Retinal fundus photograph:
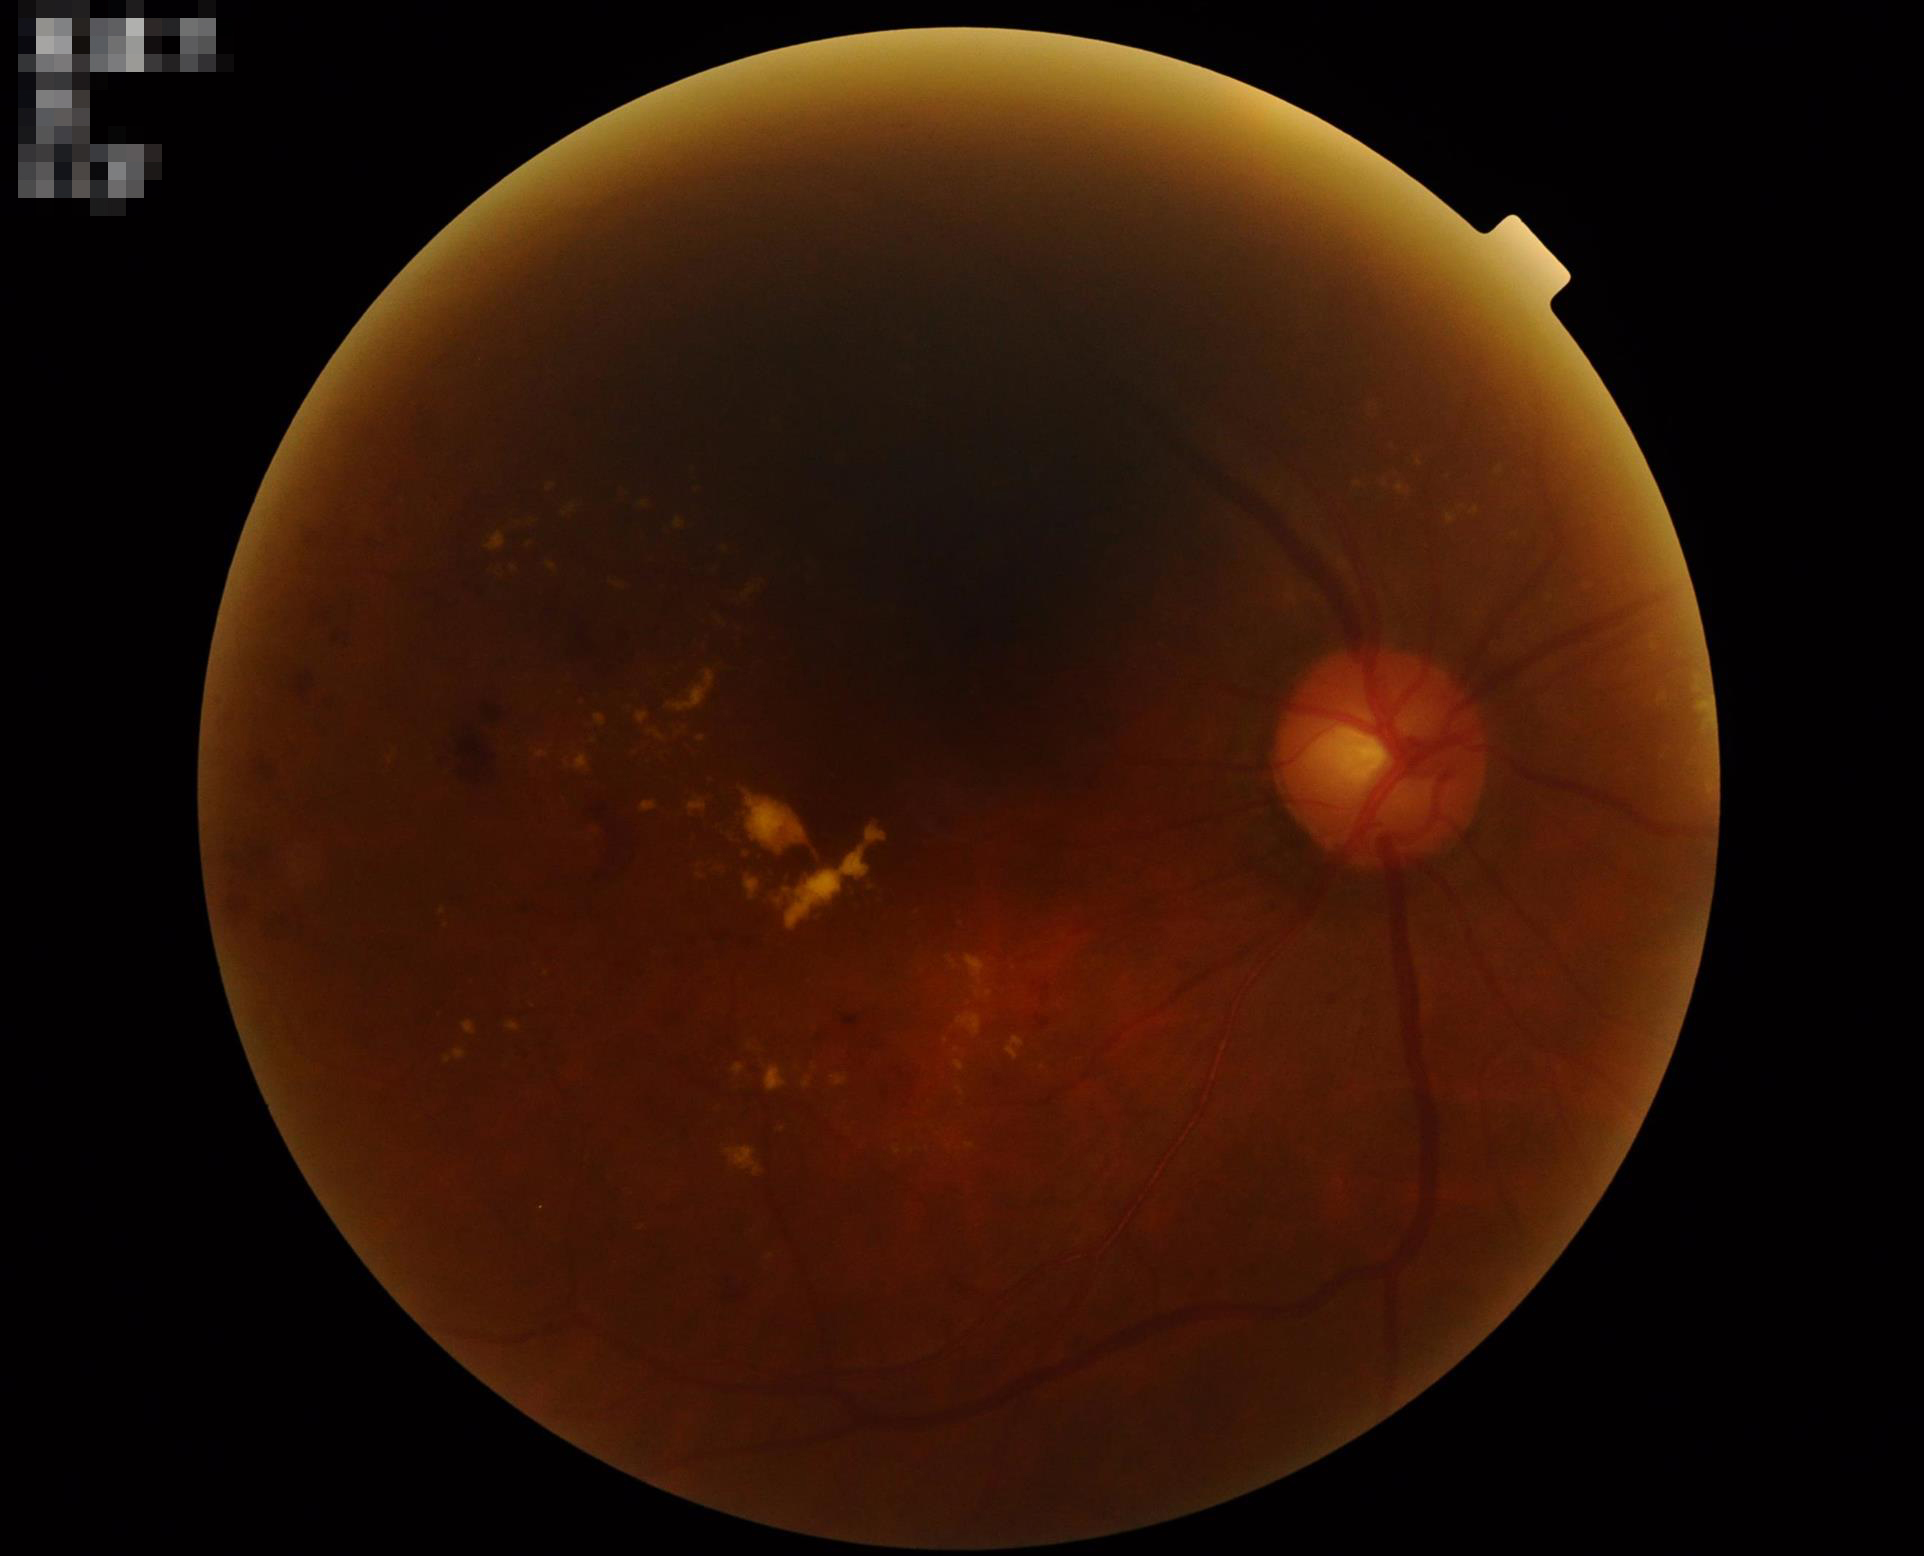

Quality grading: contrast: low; illumination: poor; clarity: in focus; overall: inadequate.